1240x1240. Pediatric retinal photograph (wide-field): 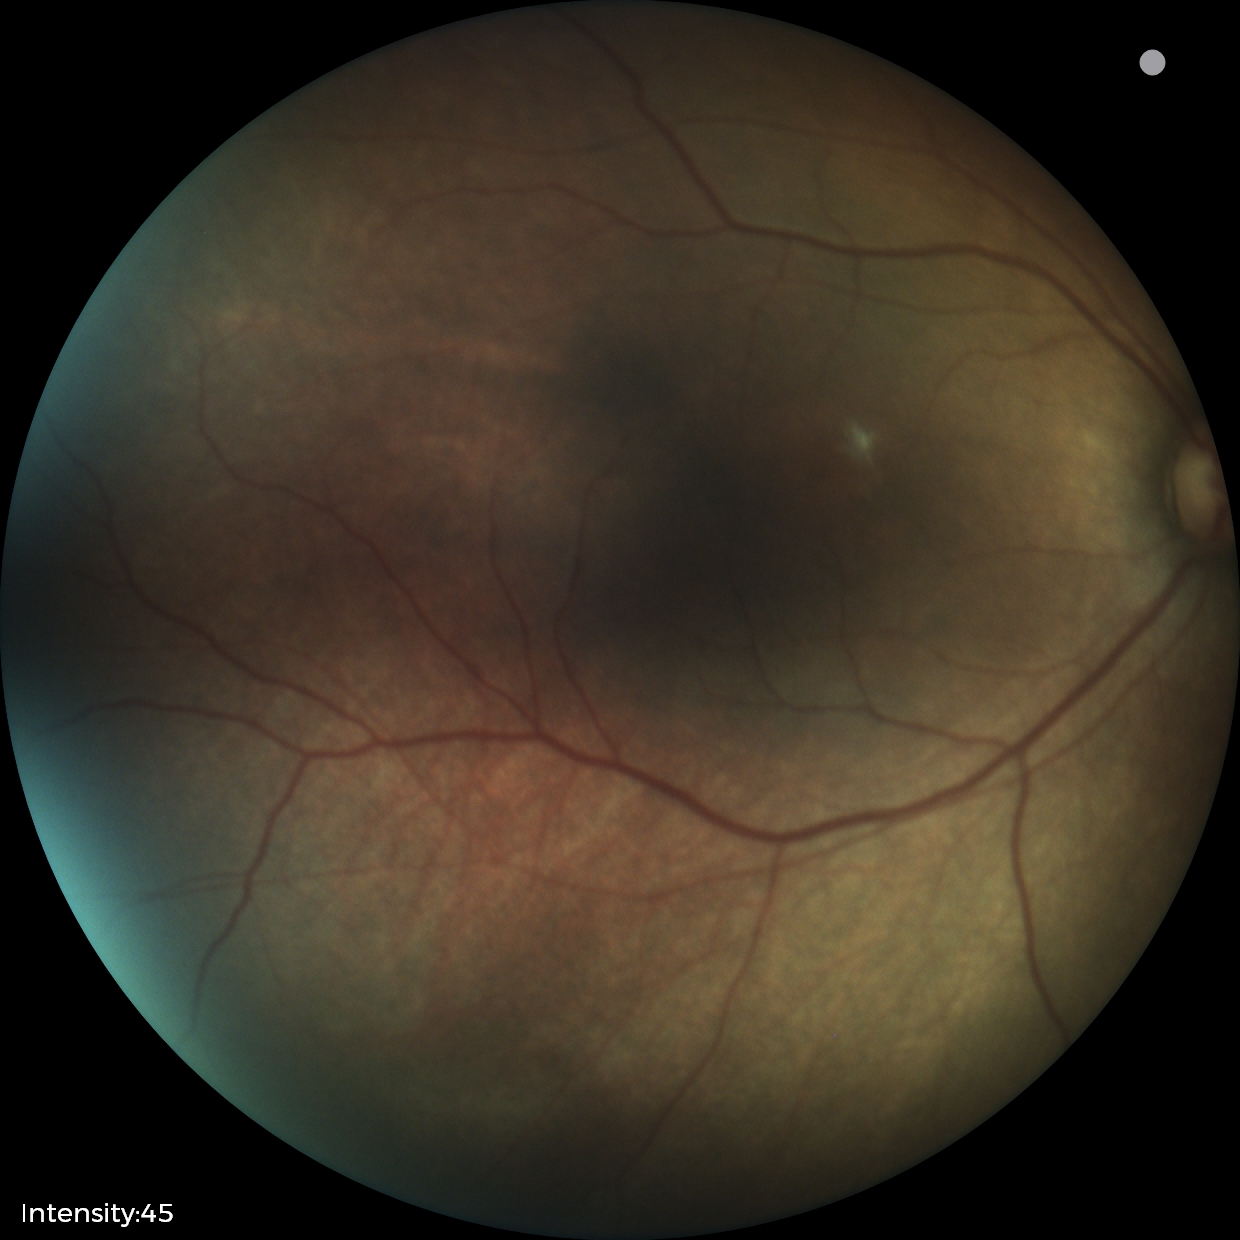

Diagnosis from this screening exam: status post retinopathy of prematurity (ROP). Plus disease absent.